Color fundus photograph, 2352 by 1568 pixels: 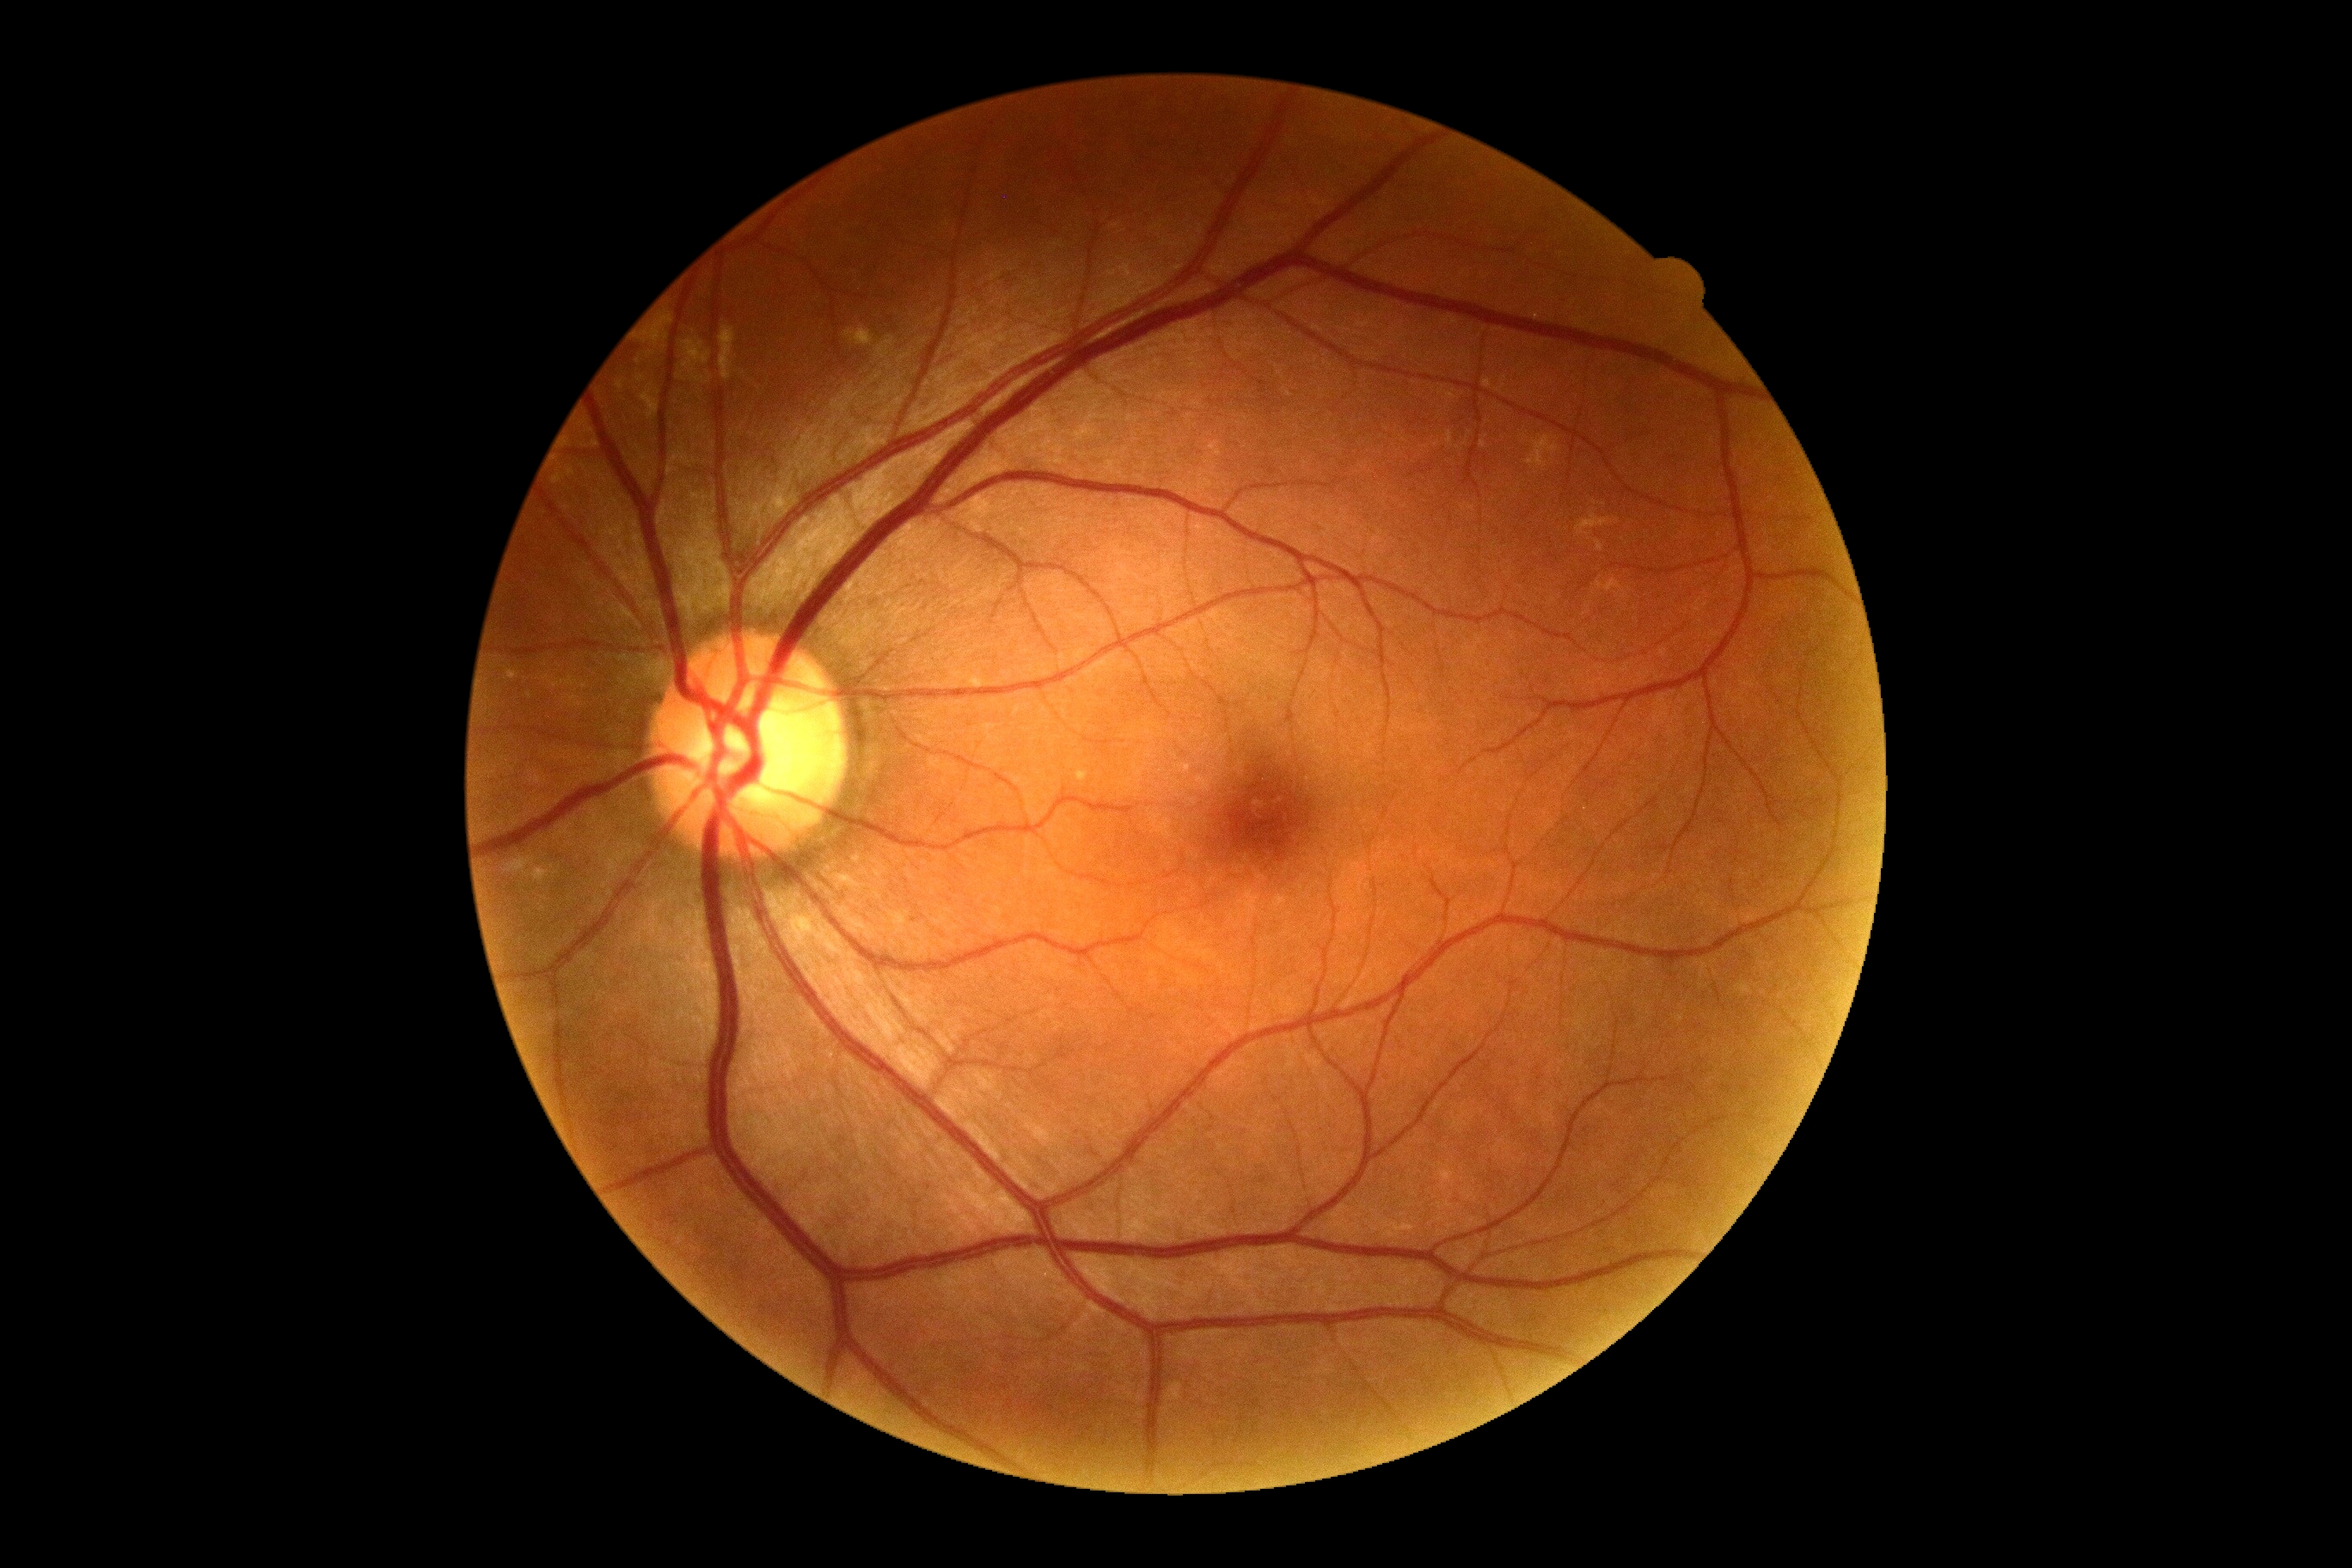 DR is grade 0 (no apparent retinopathy).